Pupil-dilated. 2228x1652. Central posterior field. Color fundus photograph. FOV: 50 degrees. Camera: Topcon TRC-50DX — 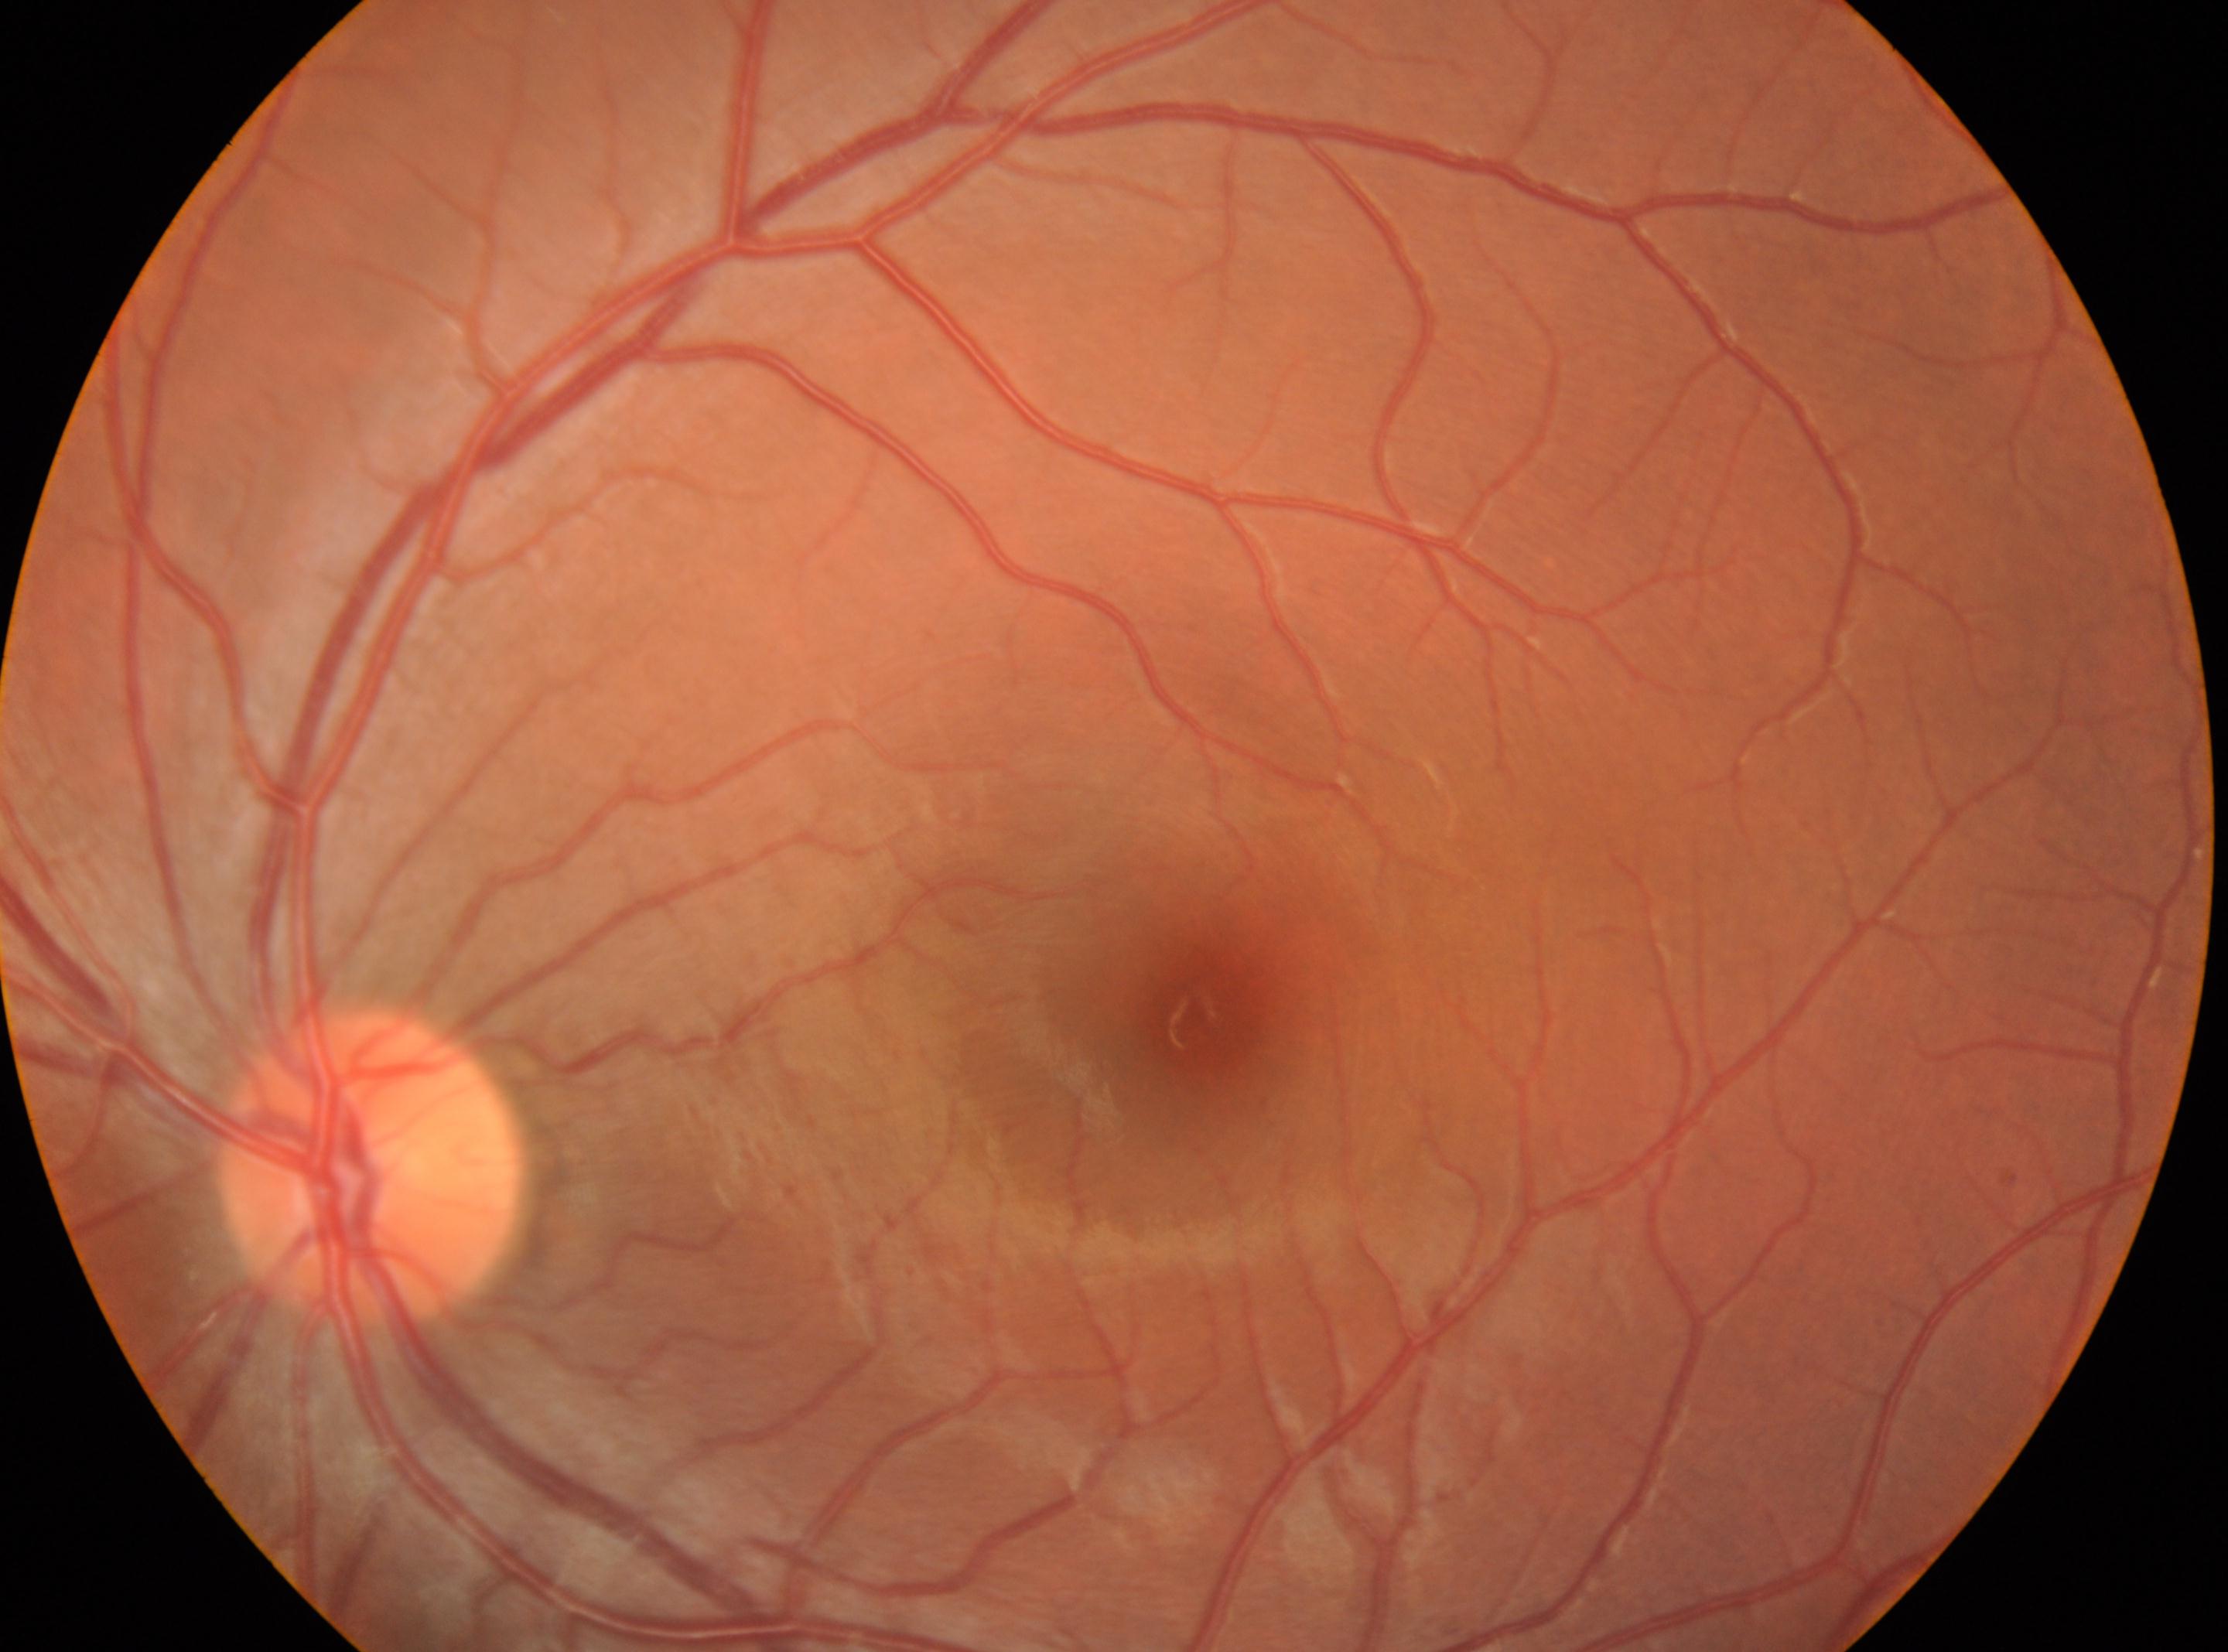

Imaged eye: the left eye. Diabetic retinopathy severity: grade 0. Macula center located at 1190px, 1019px. Optic nerve head located at 368px, 1169px.